Color fundus image. NIDEK AFC-230. Nonmydriatic: 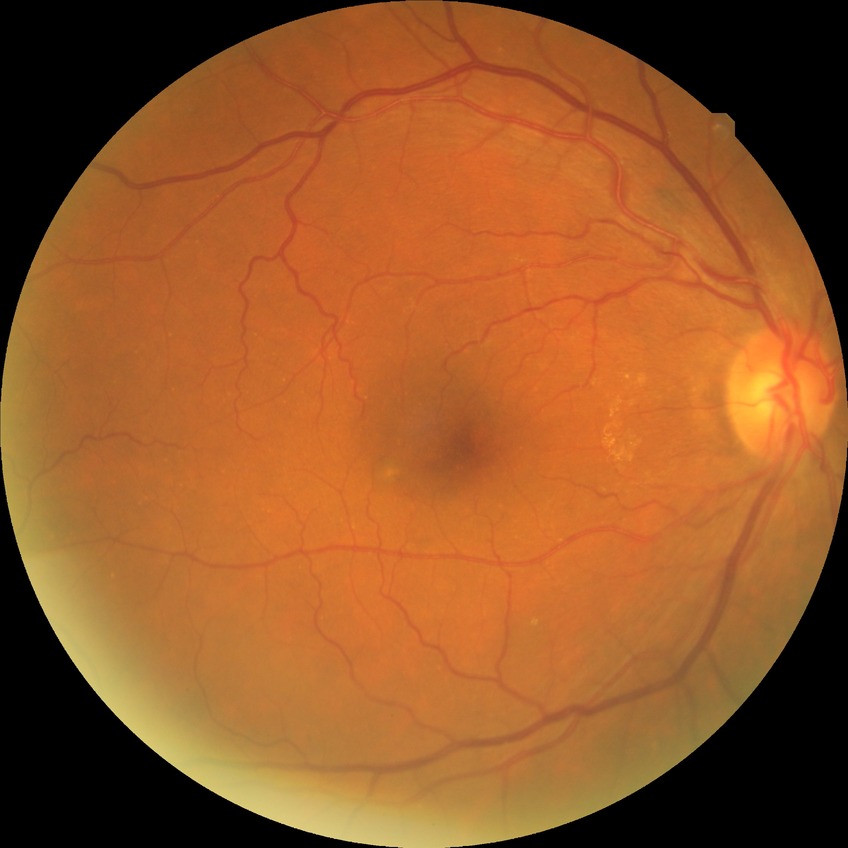

Diabetic retinopathy (DR): no diabetic retinopathy (NDR).